NIDEK AFC-230: 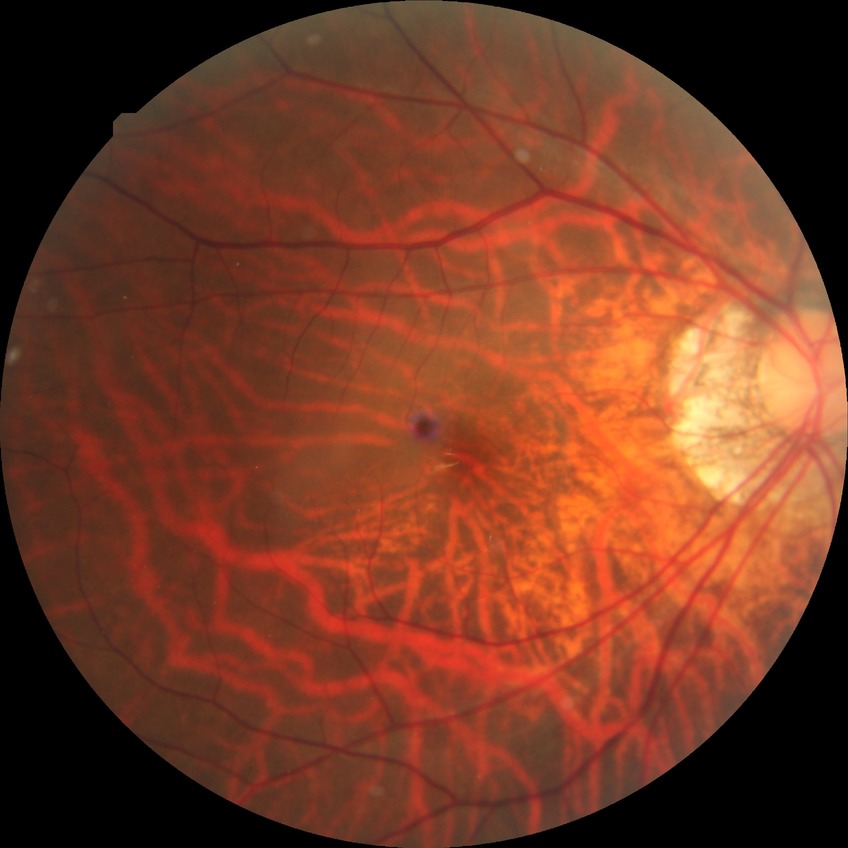 Diabetic retinopathy (DR) is NDR (no diabetic retinopathy).